45° field of view, 848x848, acquired with a NIDEK AFC-230, fundus photo, no pharmacologic dilation:
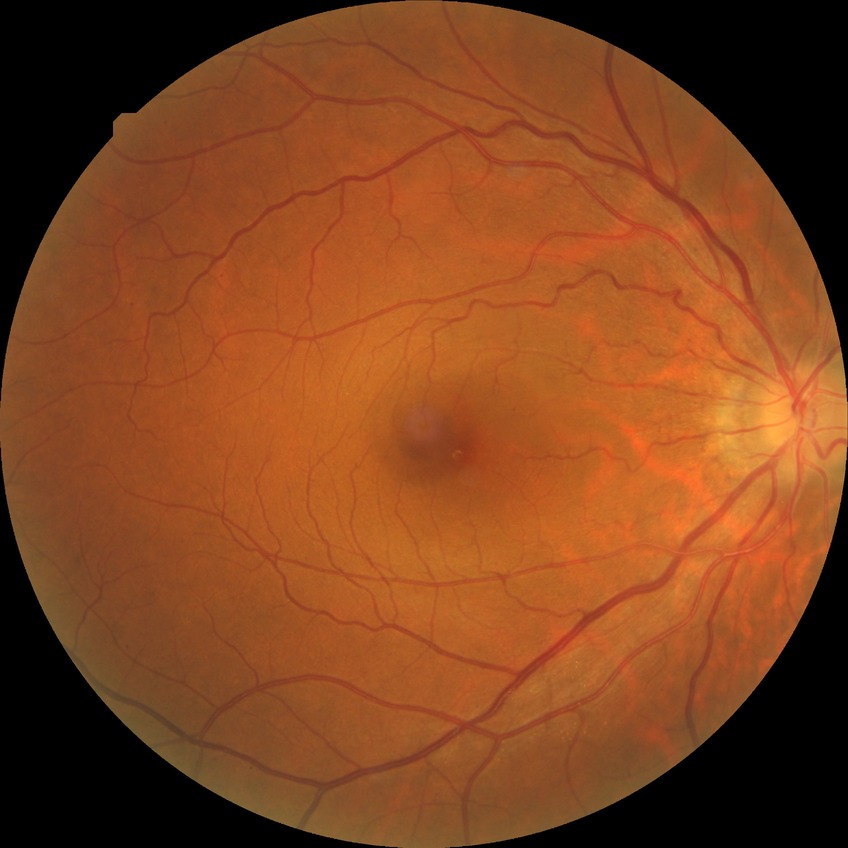

diabetic retinopathy (DR)=SDR (simple diabetic retinopathy).